Color fundus photograph
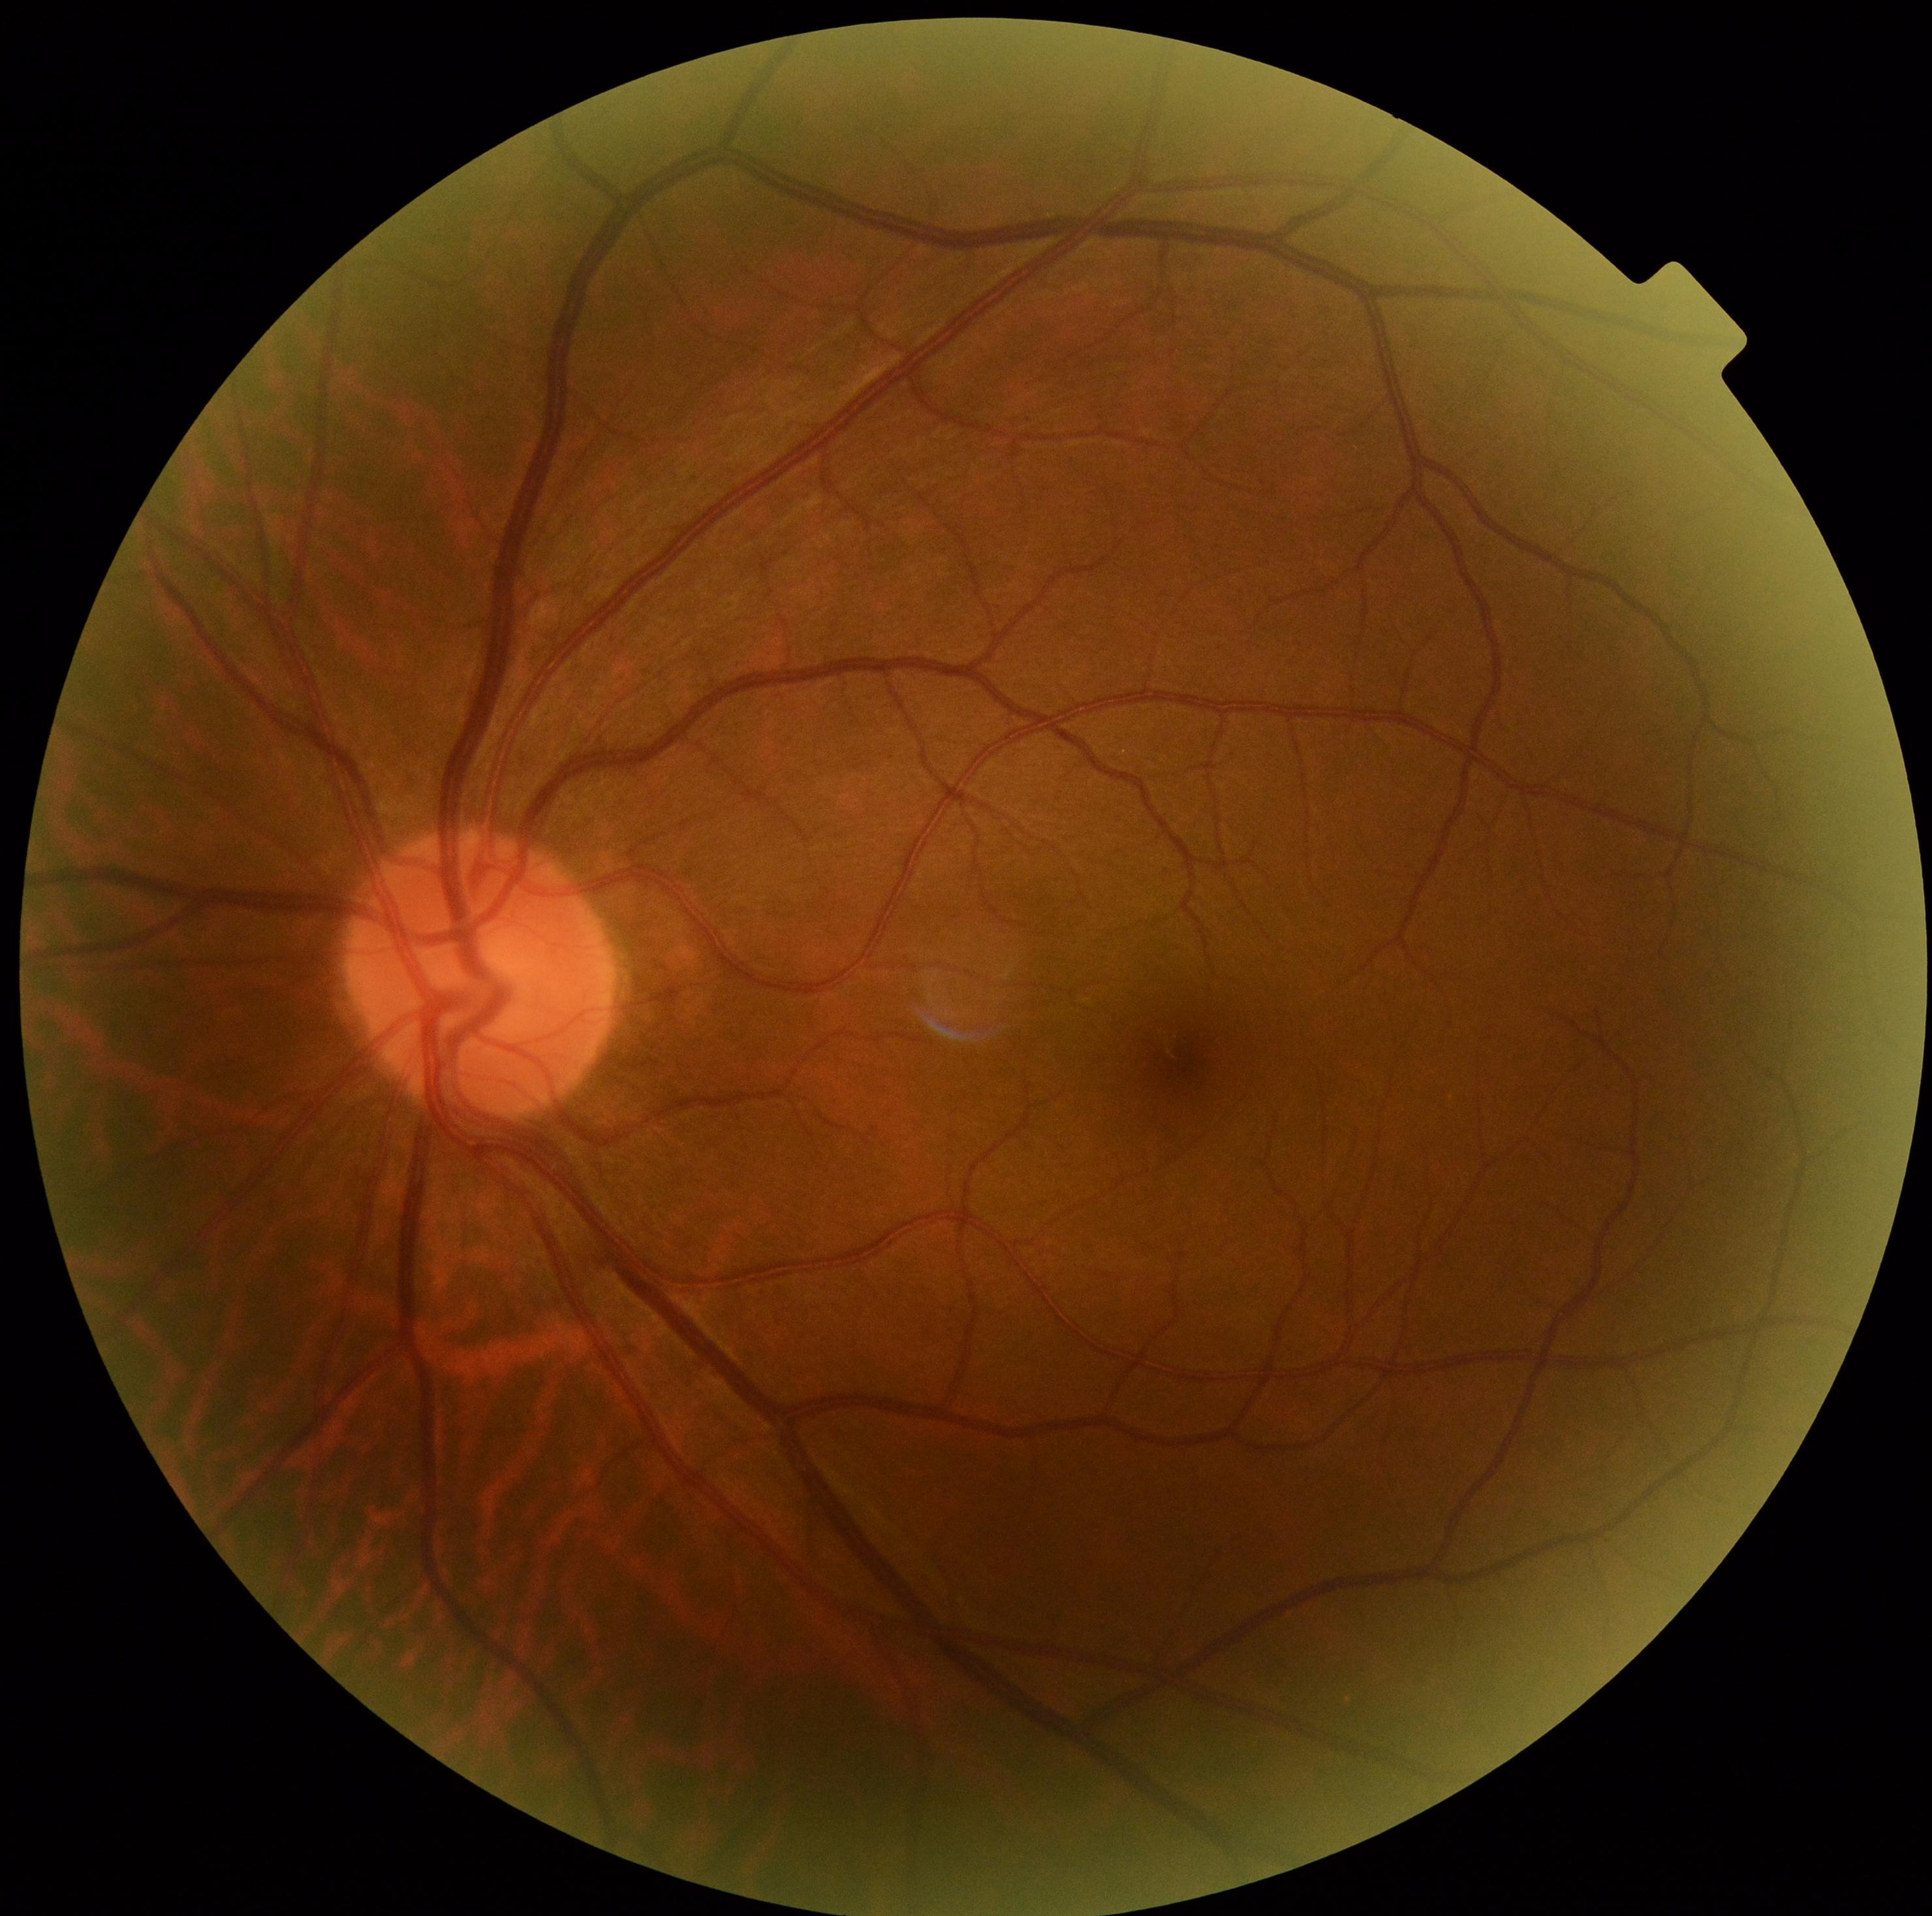

– DR severity — 0